Image size 848x848, NIDEK AFC-230:
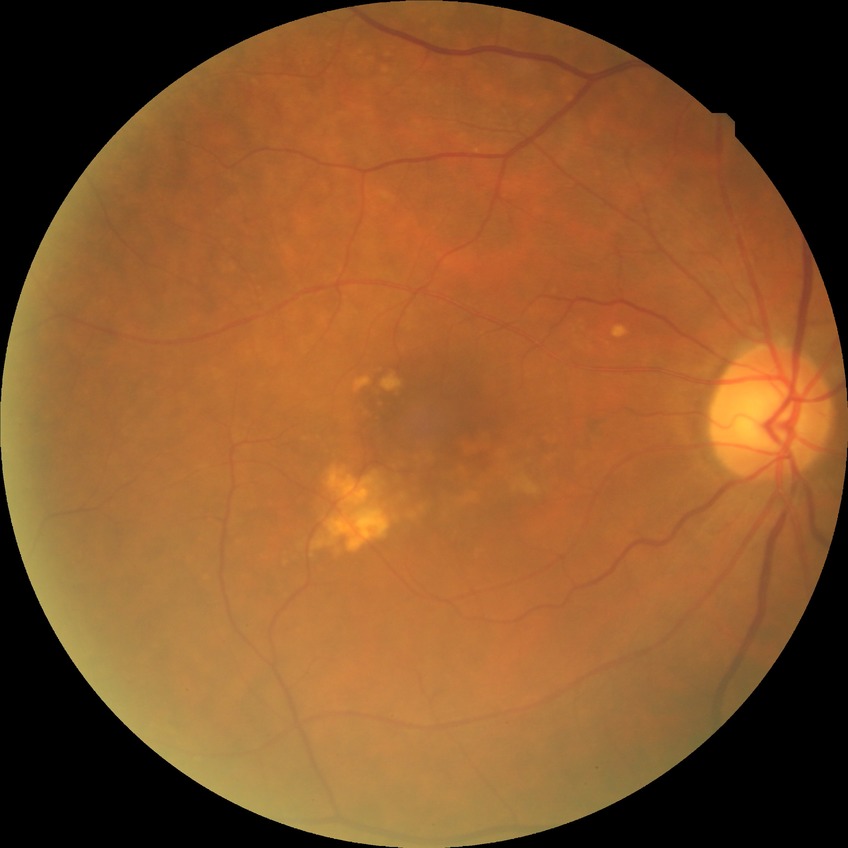

diabetic retinopathy (DR): no diabetic retinopathy (NDR)